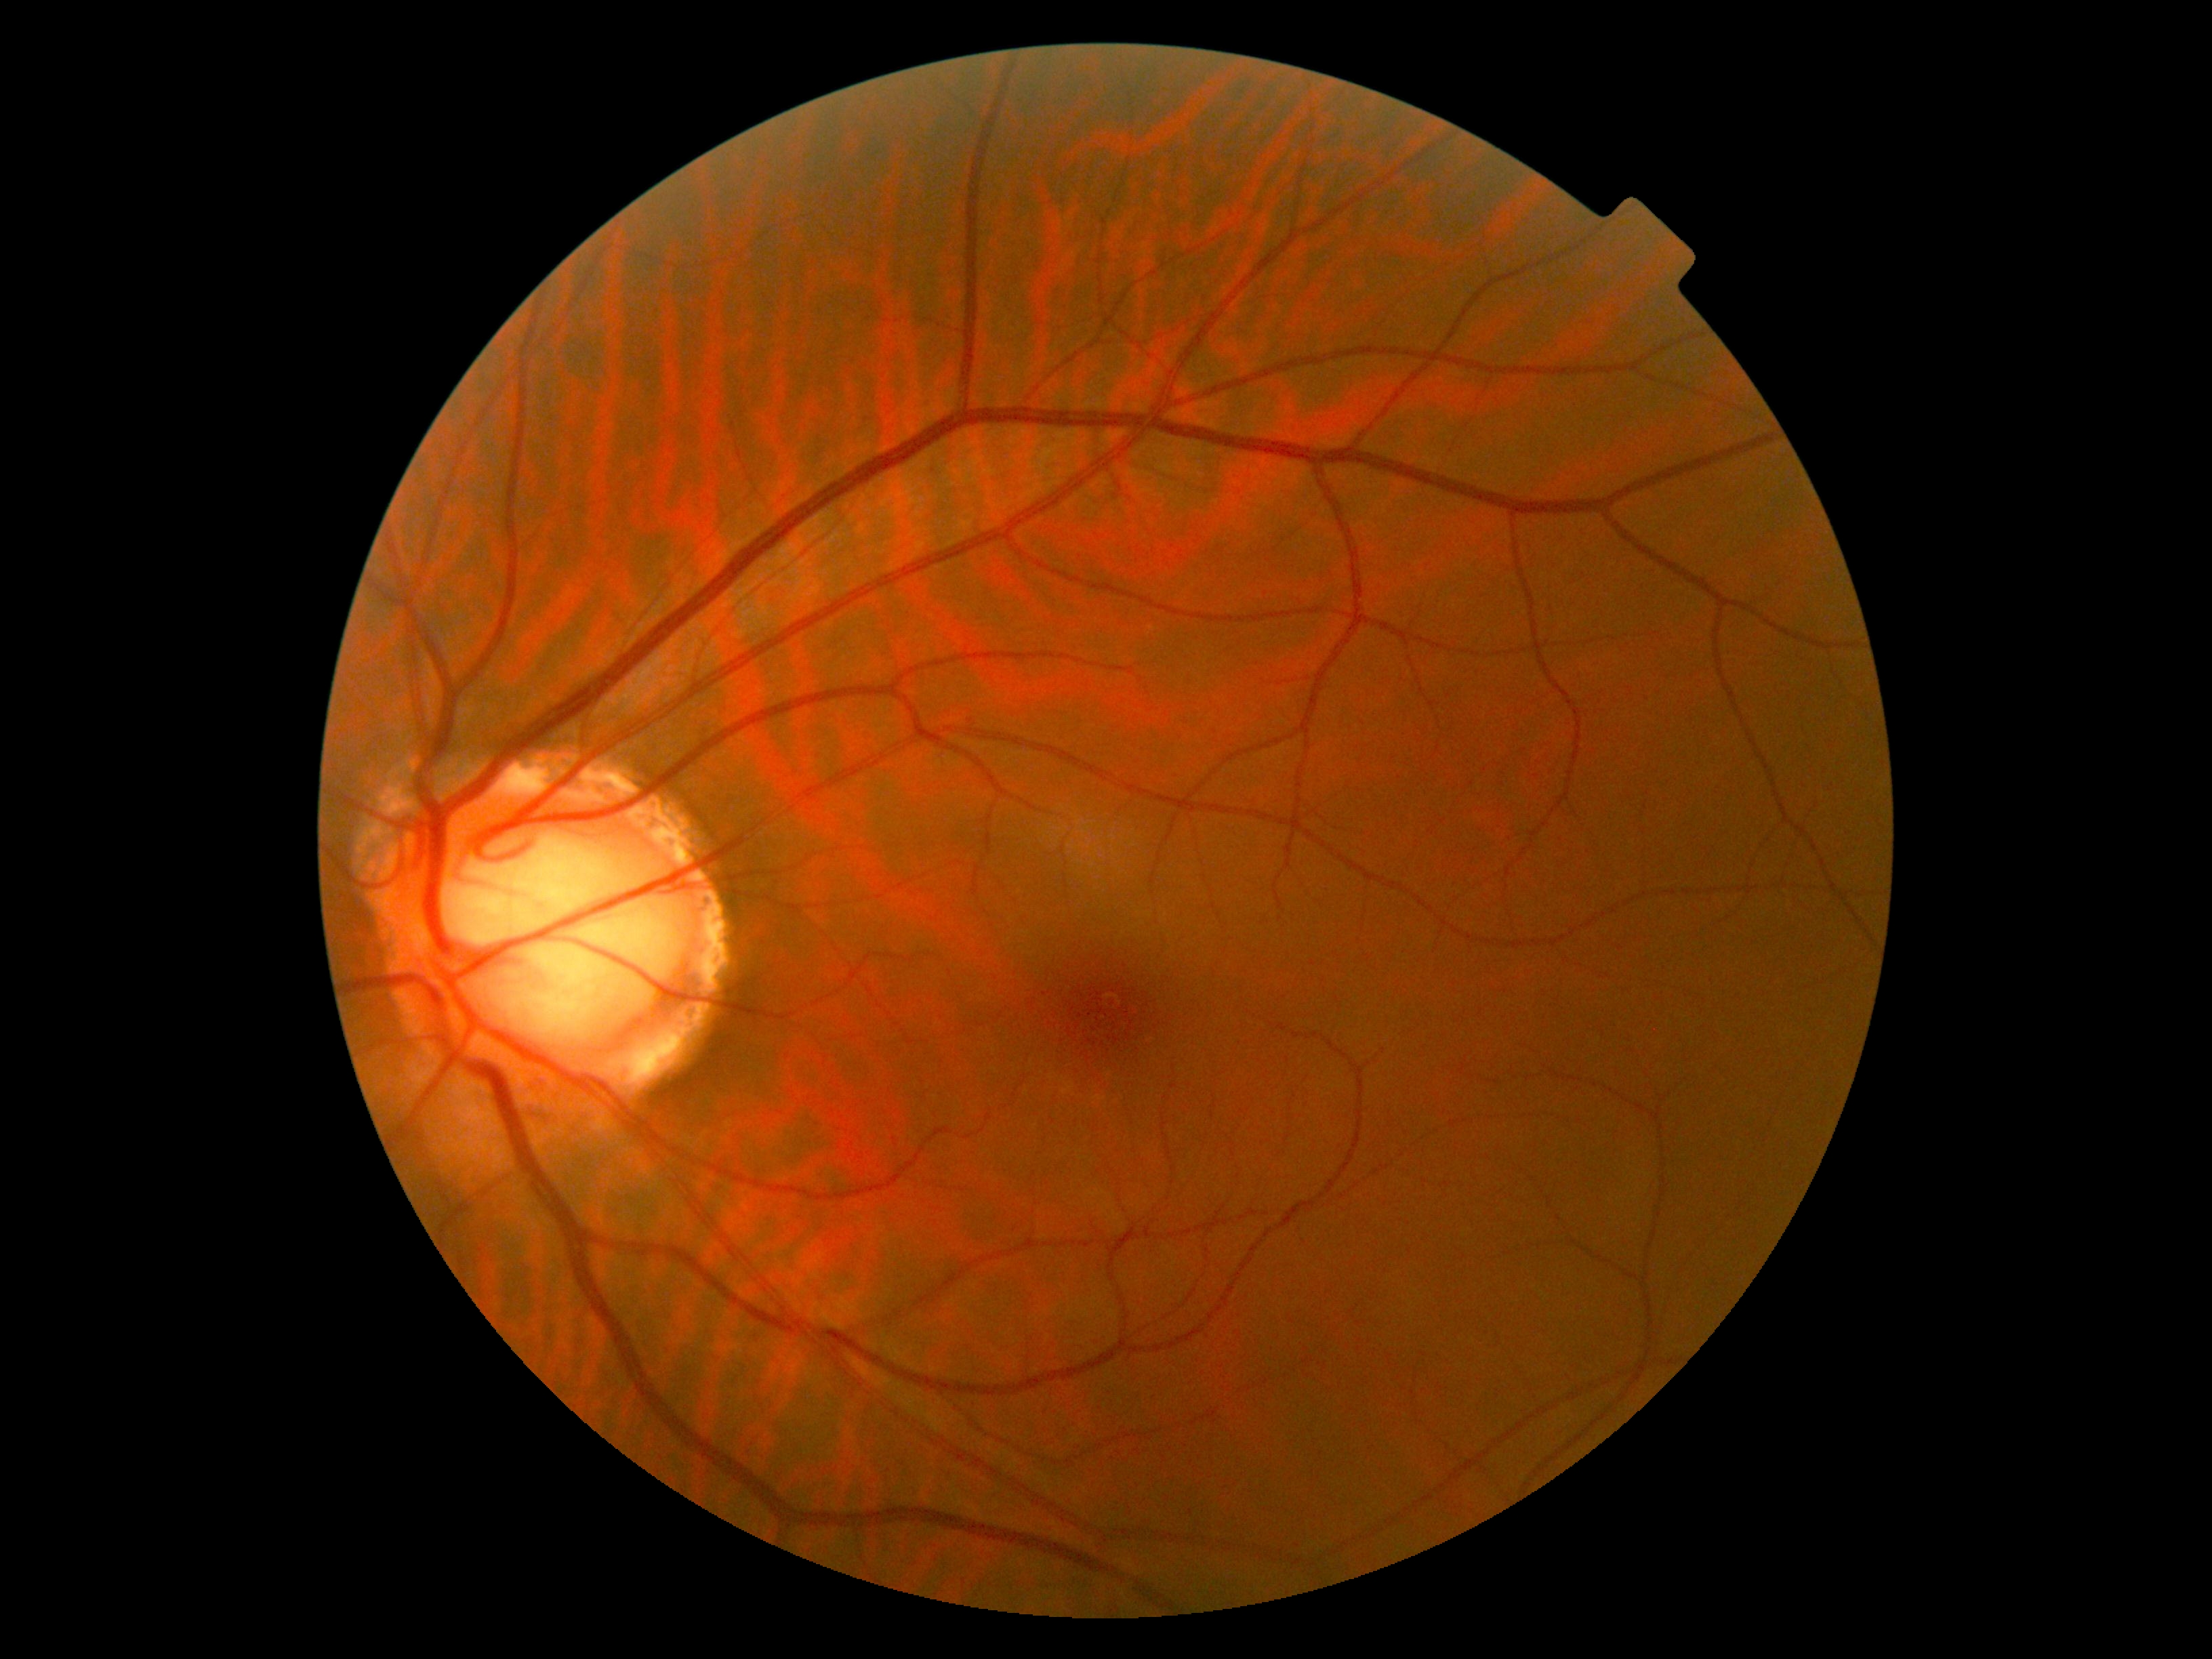

Diabetic retinopathy: 0/4.